Camera: Remidio Fundus on Phone.
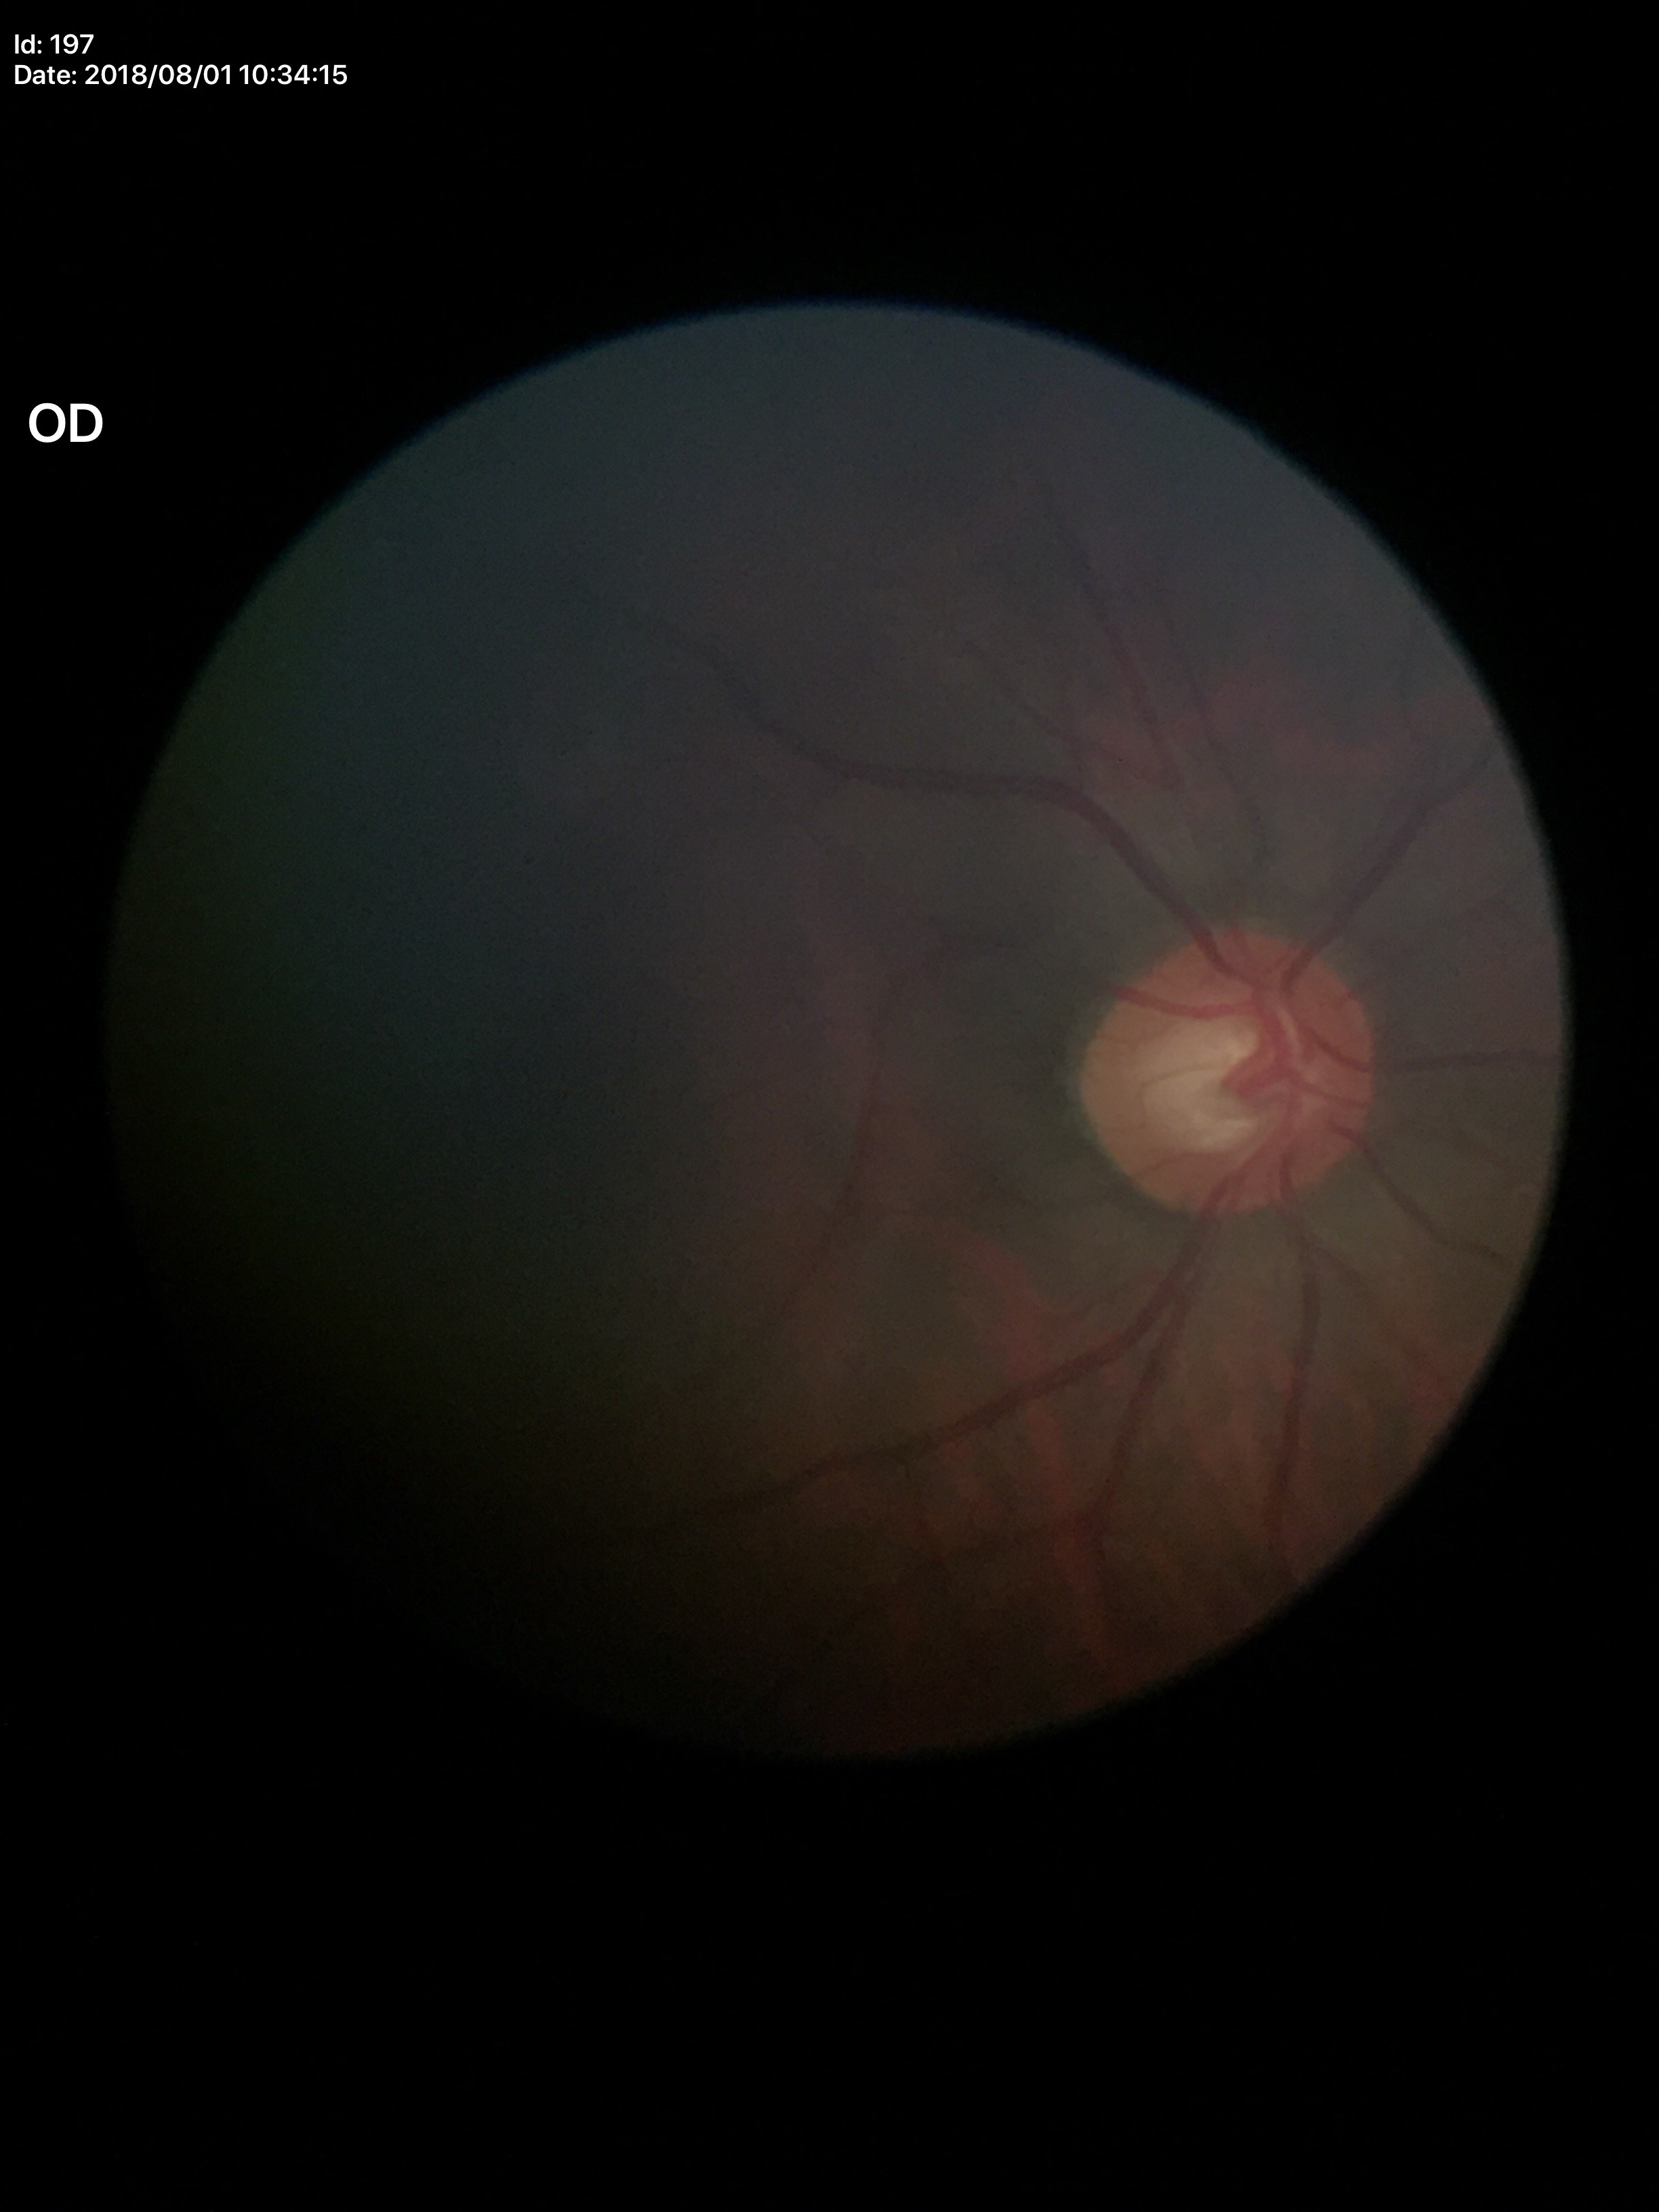
Glaucoma assessment: not suspect.
Vertical C/D ratio (VCDR): 0.55.
Area cup-disc ratio (ACDR): 0.31.